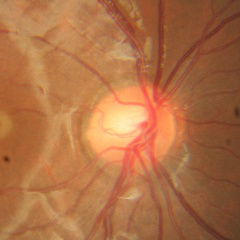

No glaucomatous findings.